Color fundus photograph
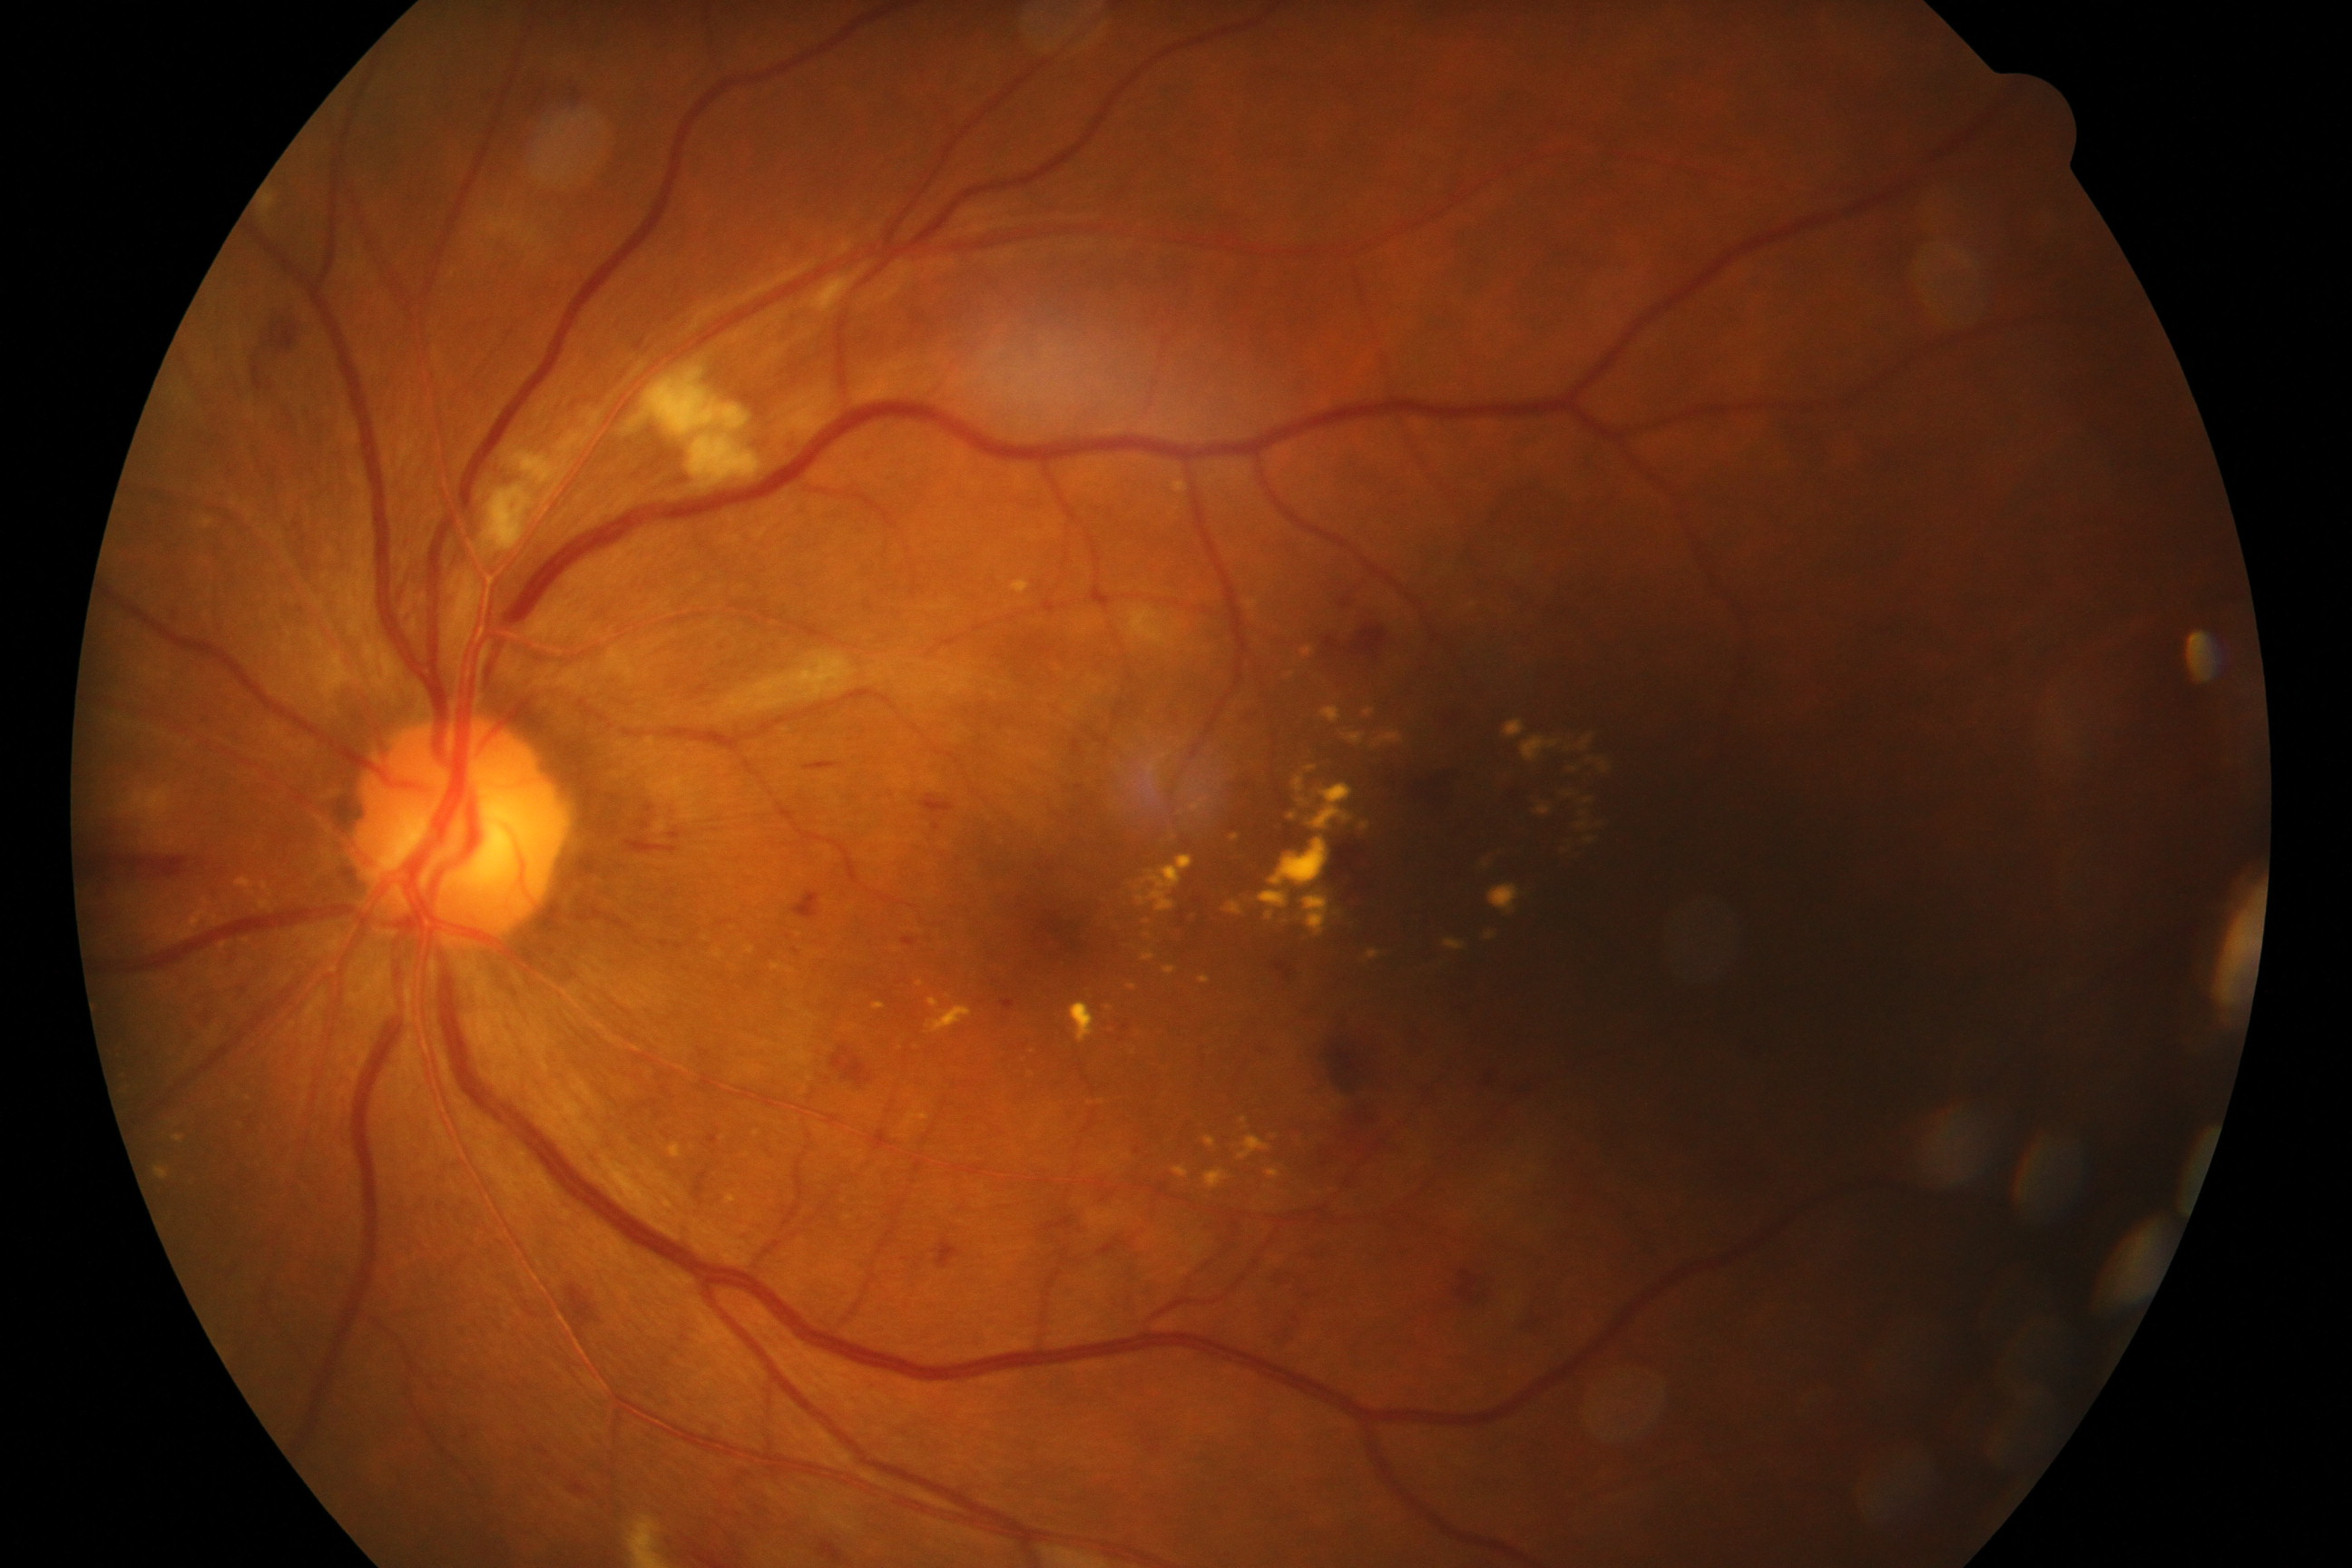 Findings: moderate non-proliferative diabetic retinopathy.